Nonmydriatic fundus photograph · 848 x 848 pixels — 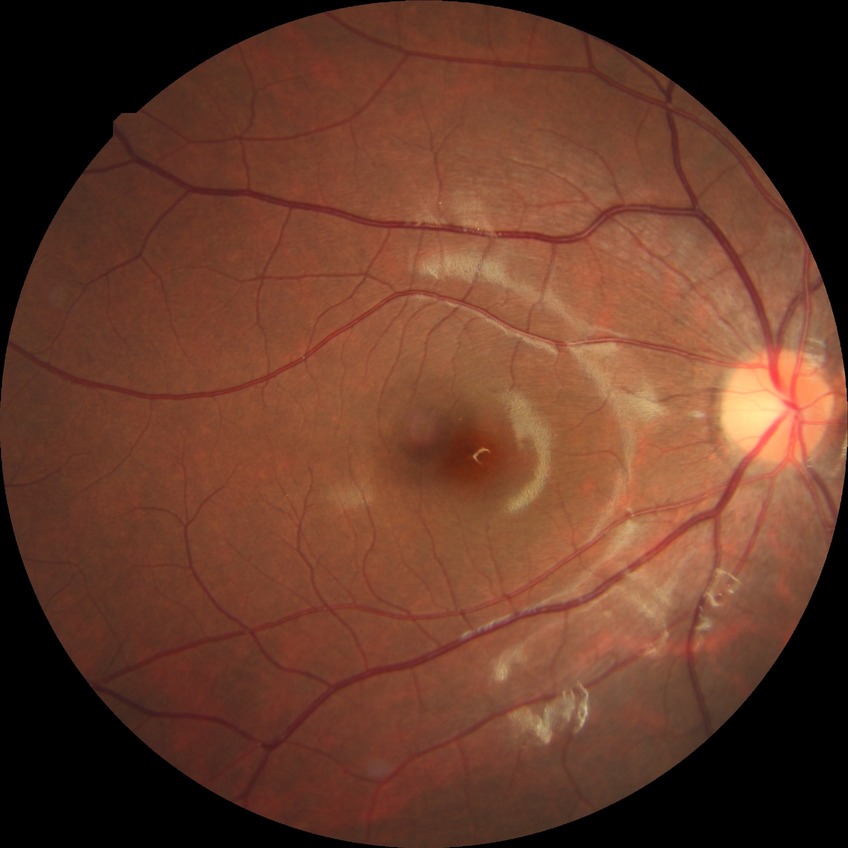 davis_grade: no diabetic retinopathy